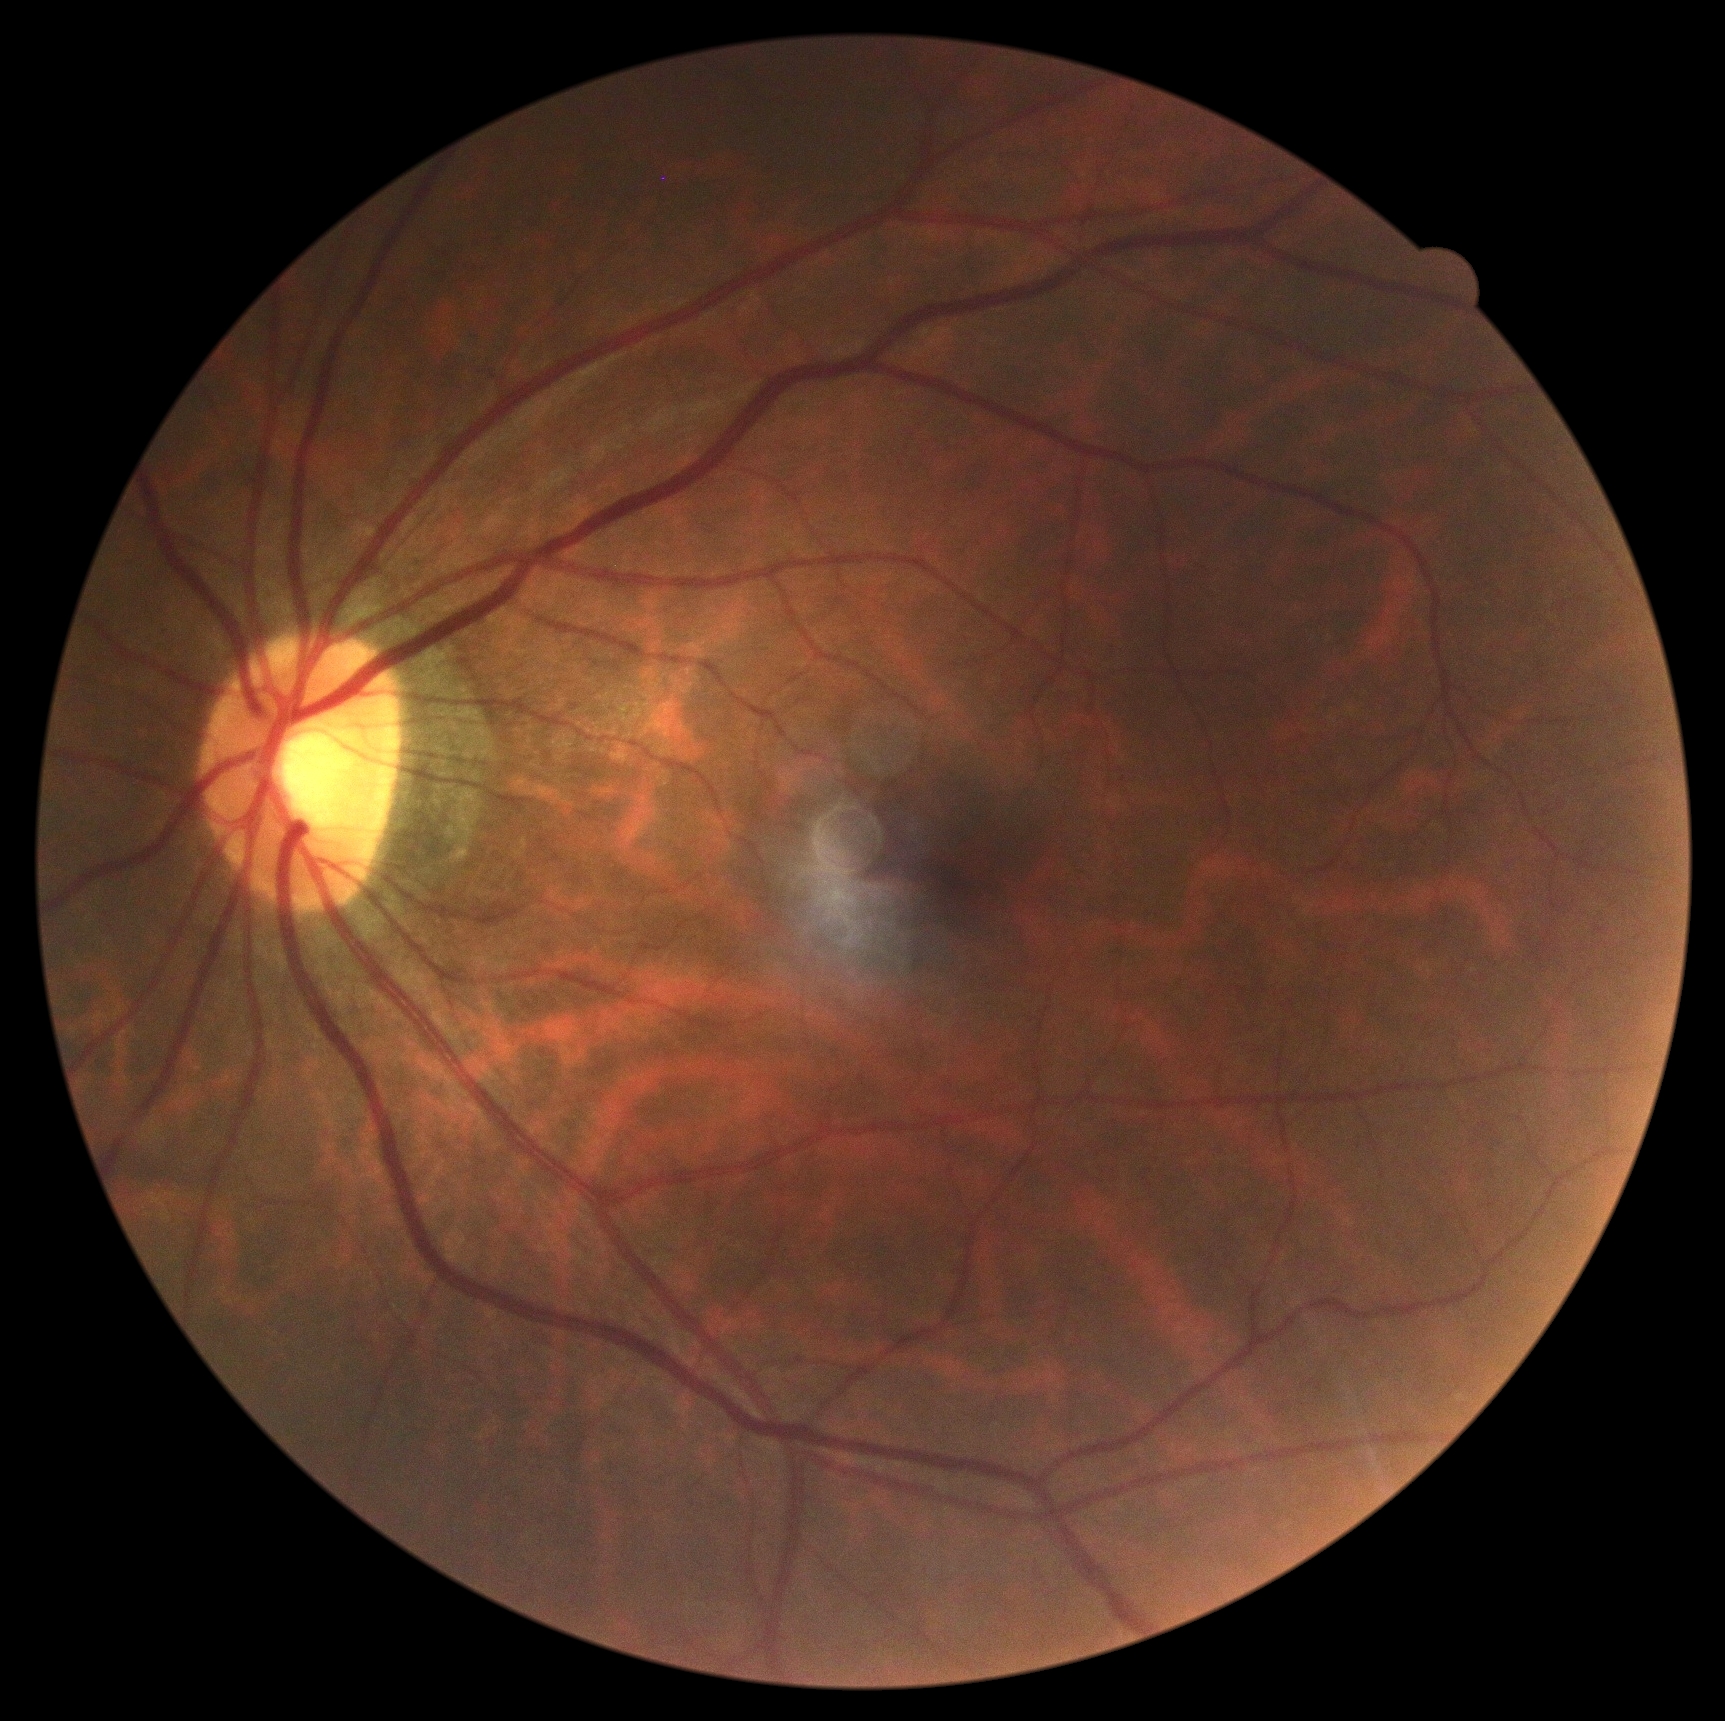 Diabetic retinopathy (DR) is grade 0 (no apparent retinopathy).